Captured on a Kowa VX-10α fundus camera — 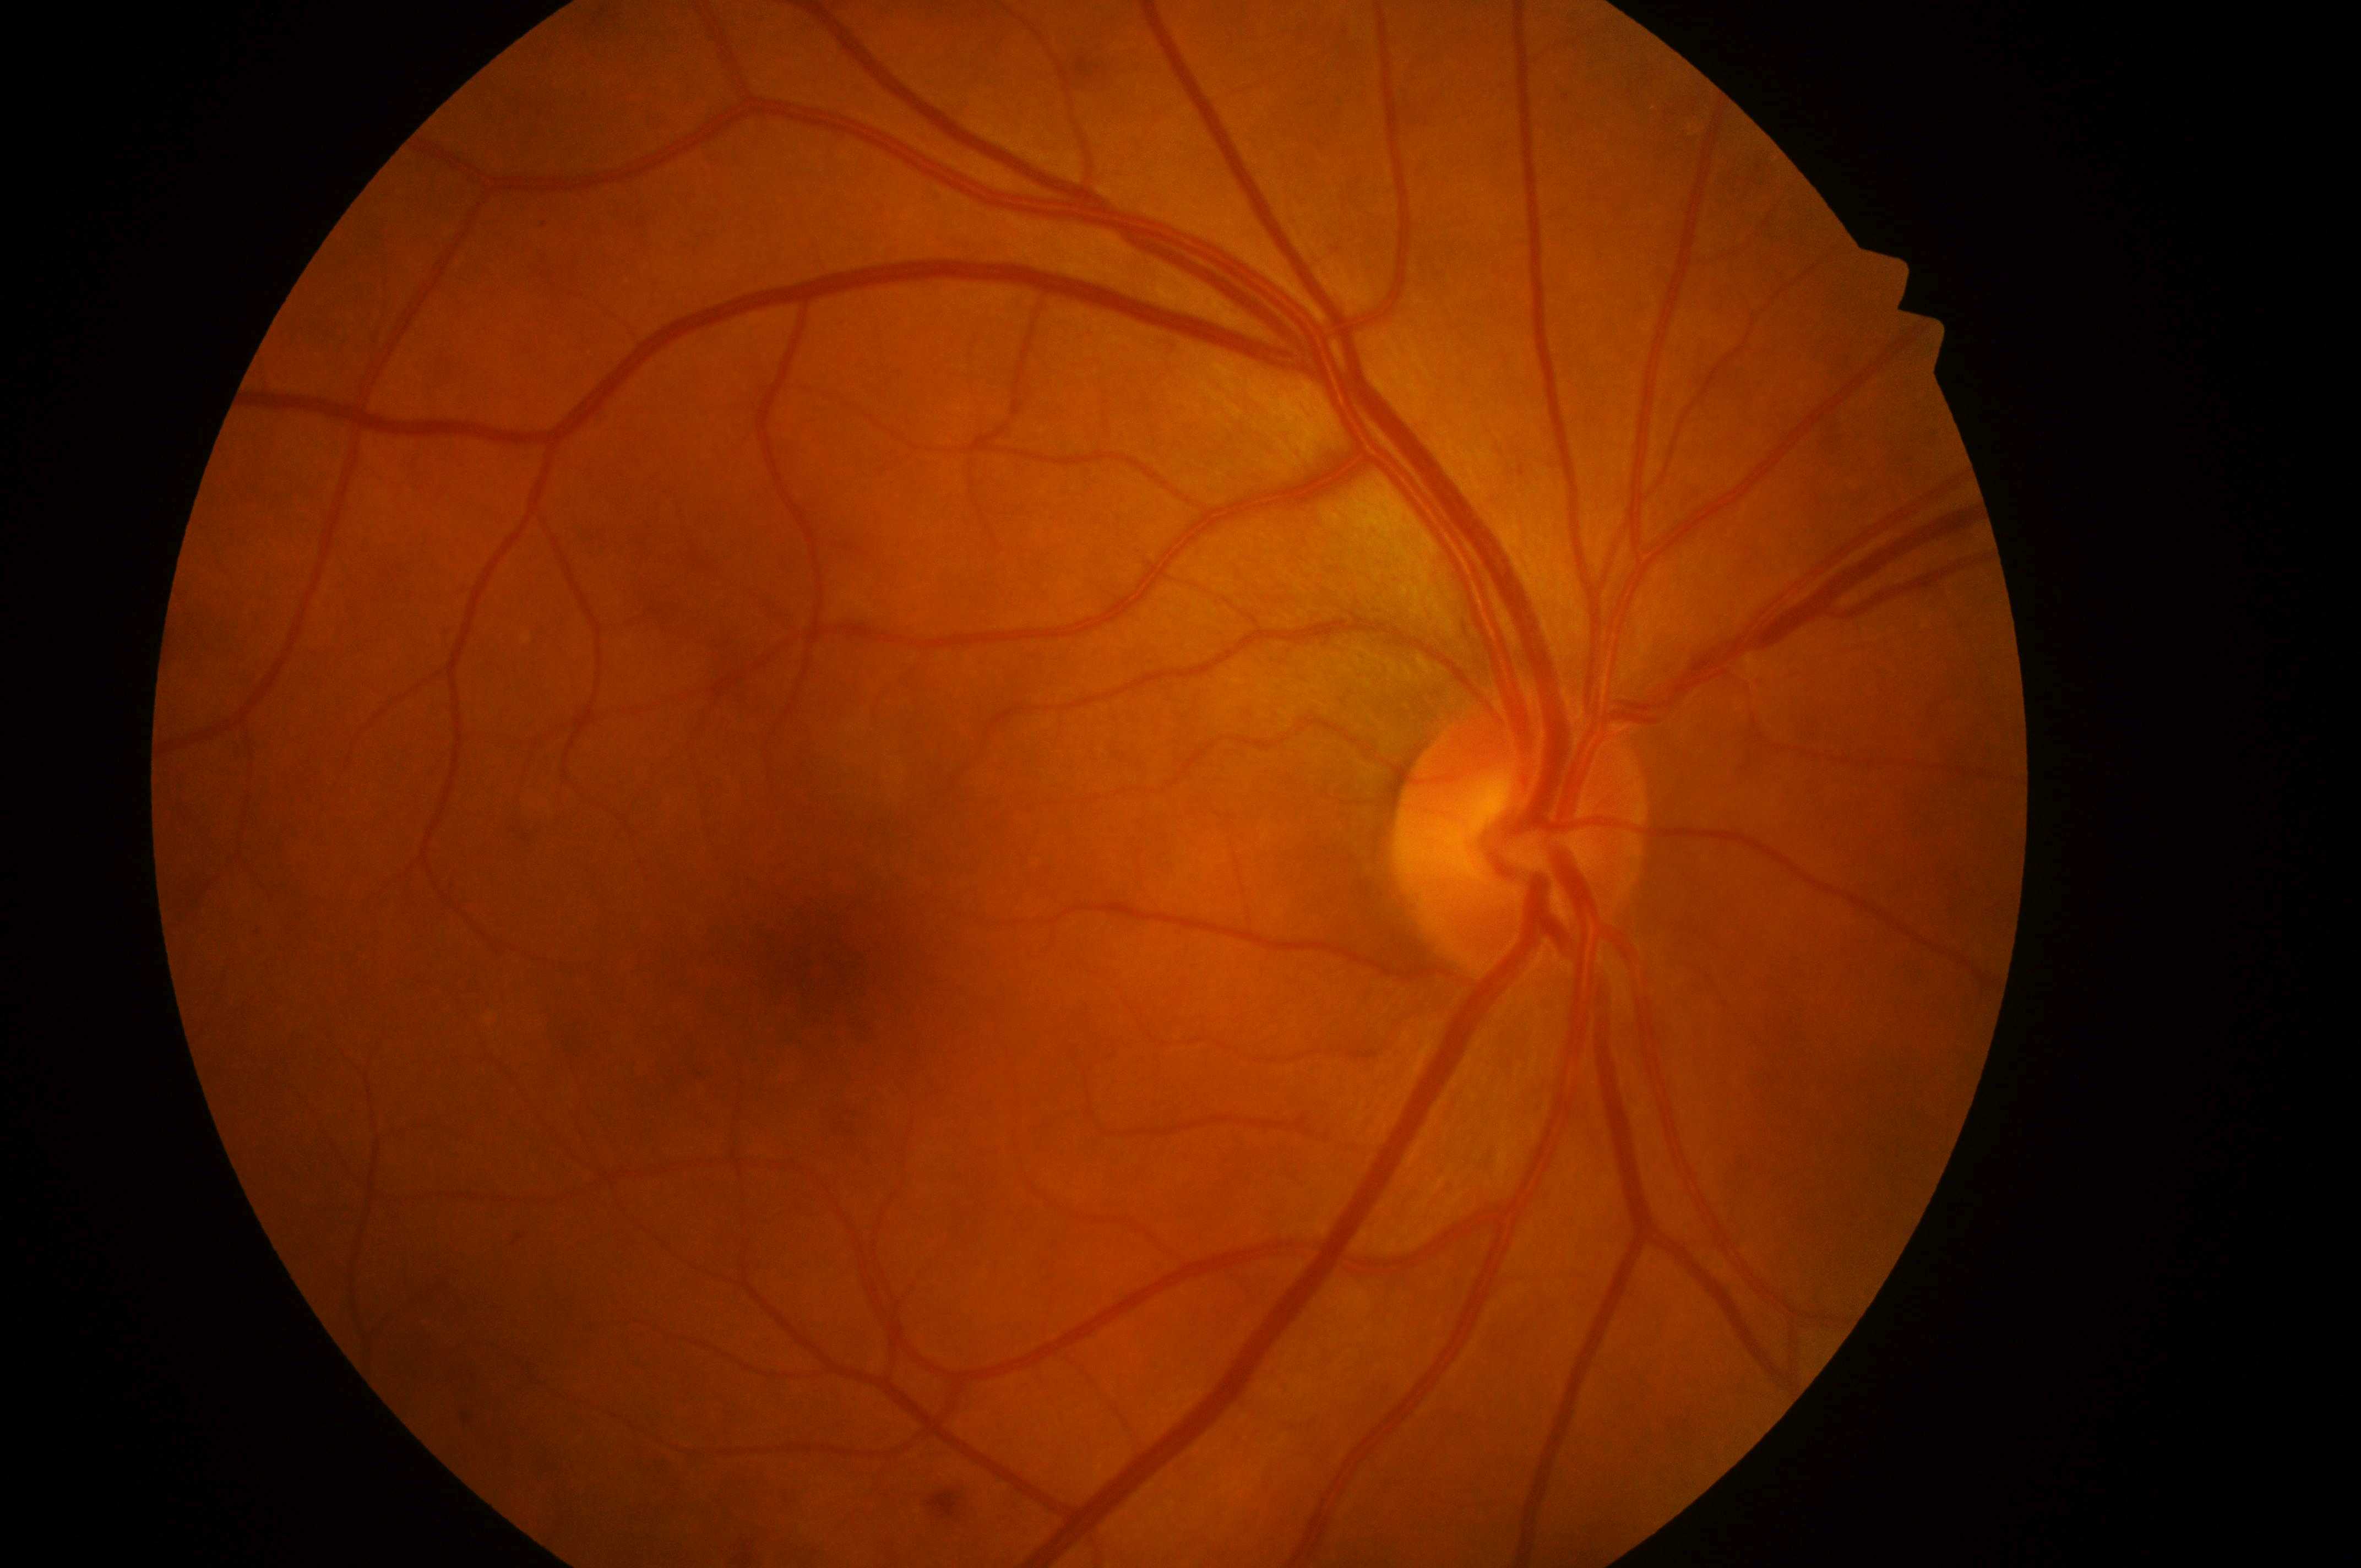 Optic disc center: 1520px, 851px. DR stage: 0 — no visible signs of diabetic retinopathy. Macular center located at 827px, 979px. DME is grade 0 — no apparent hard exudates. Imaged eye: oculus dexter.